Acquired with a NIDEK AFC-230
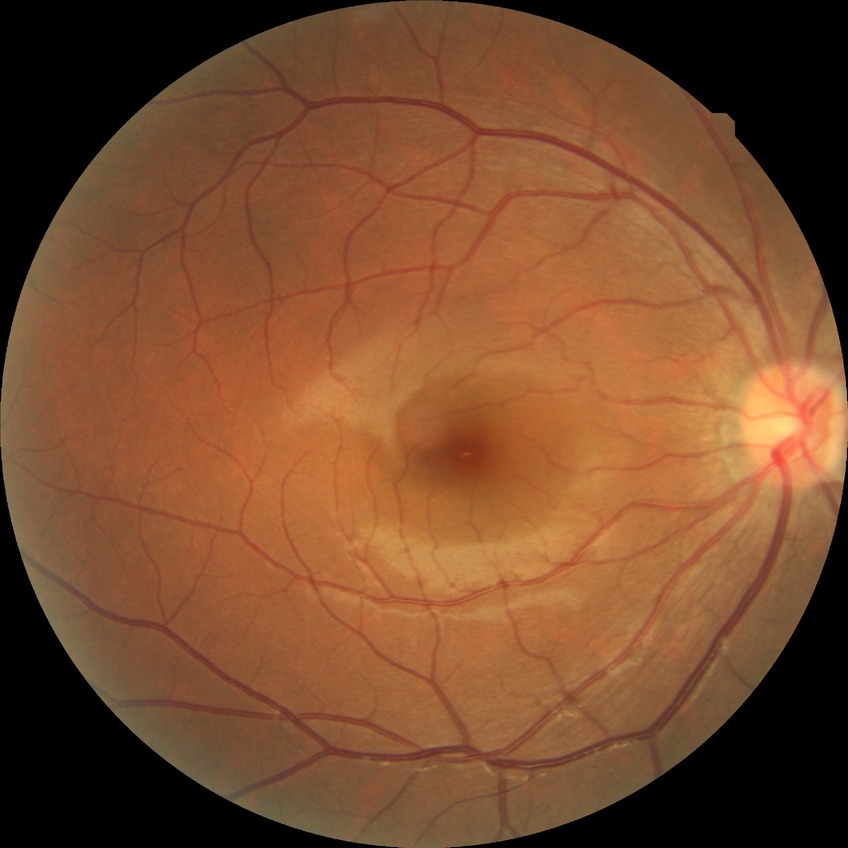
diabetic retinopathy (DR): NDR (no diabetic retinopathy).